512 x 512 pixels; retinal fundus photograph
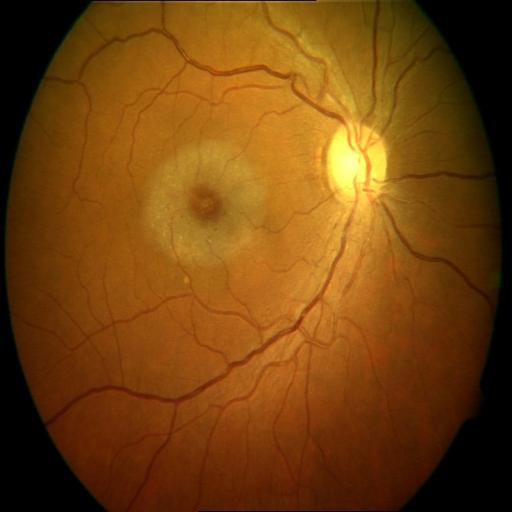 Two abnormalities. The image shows MS (macular scar) & ODP (optic disc pallor).